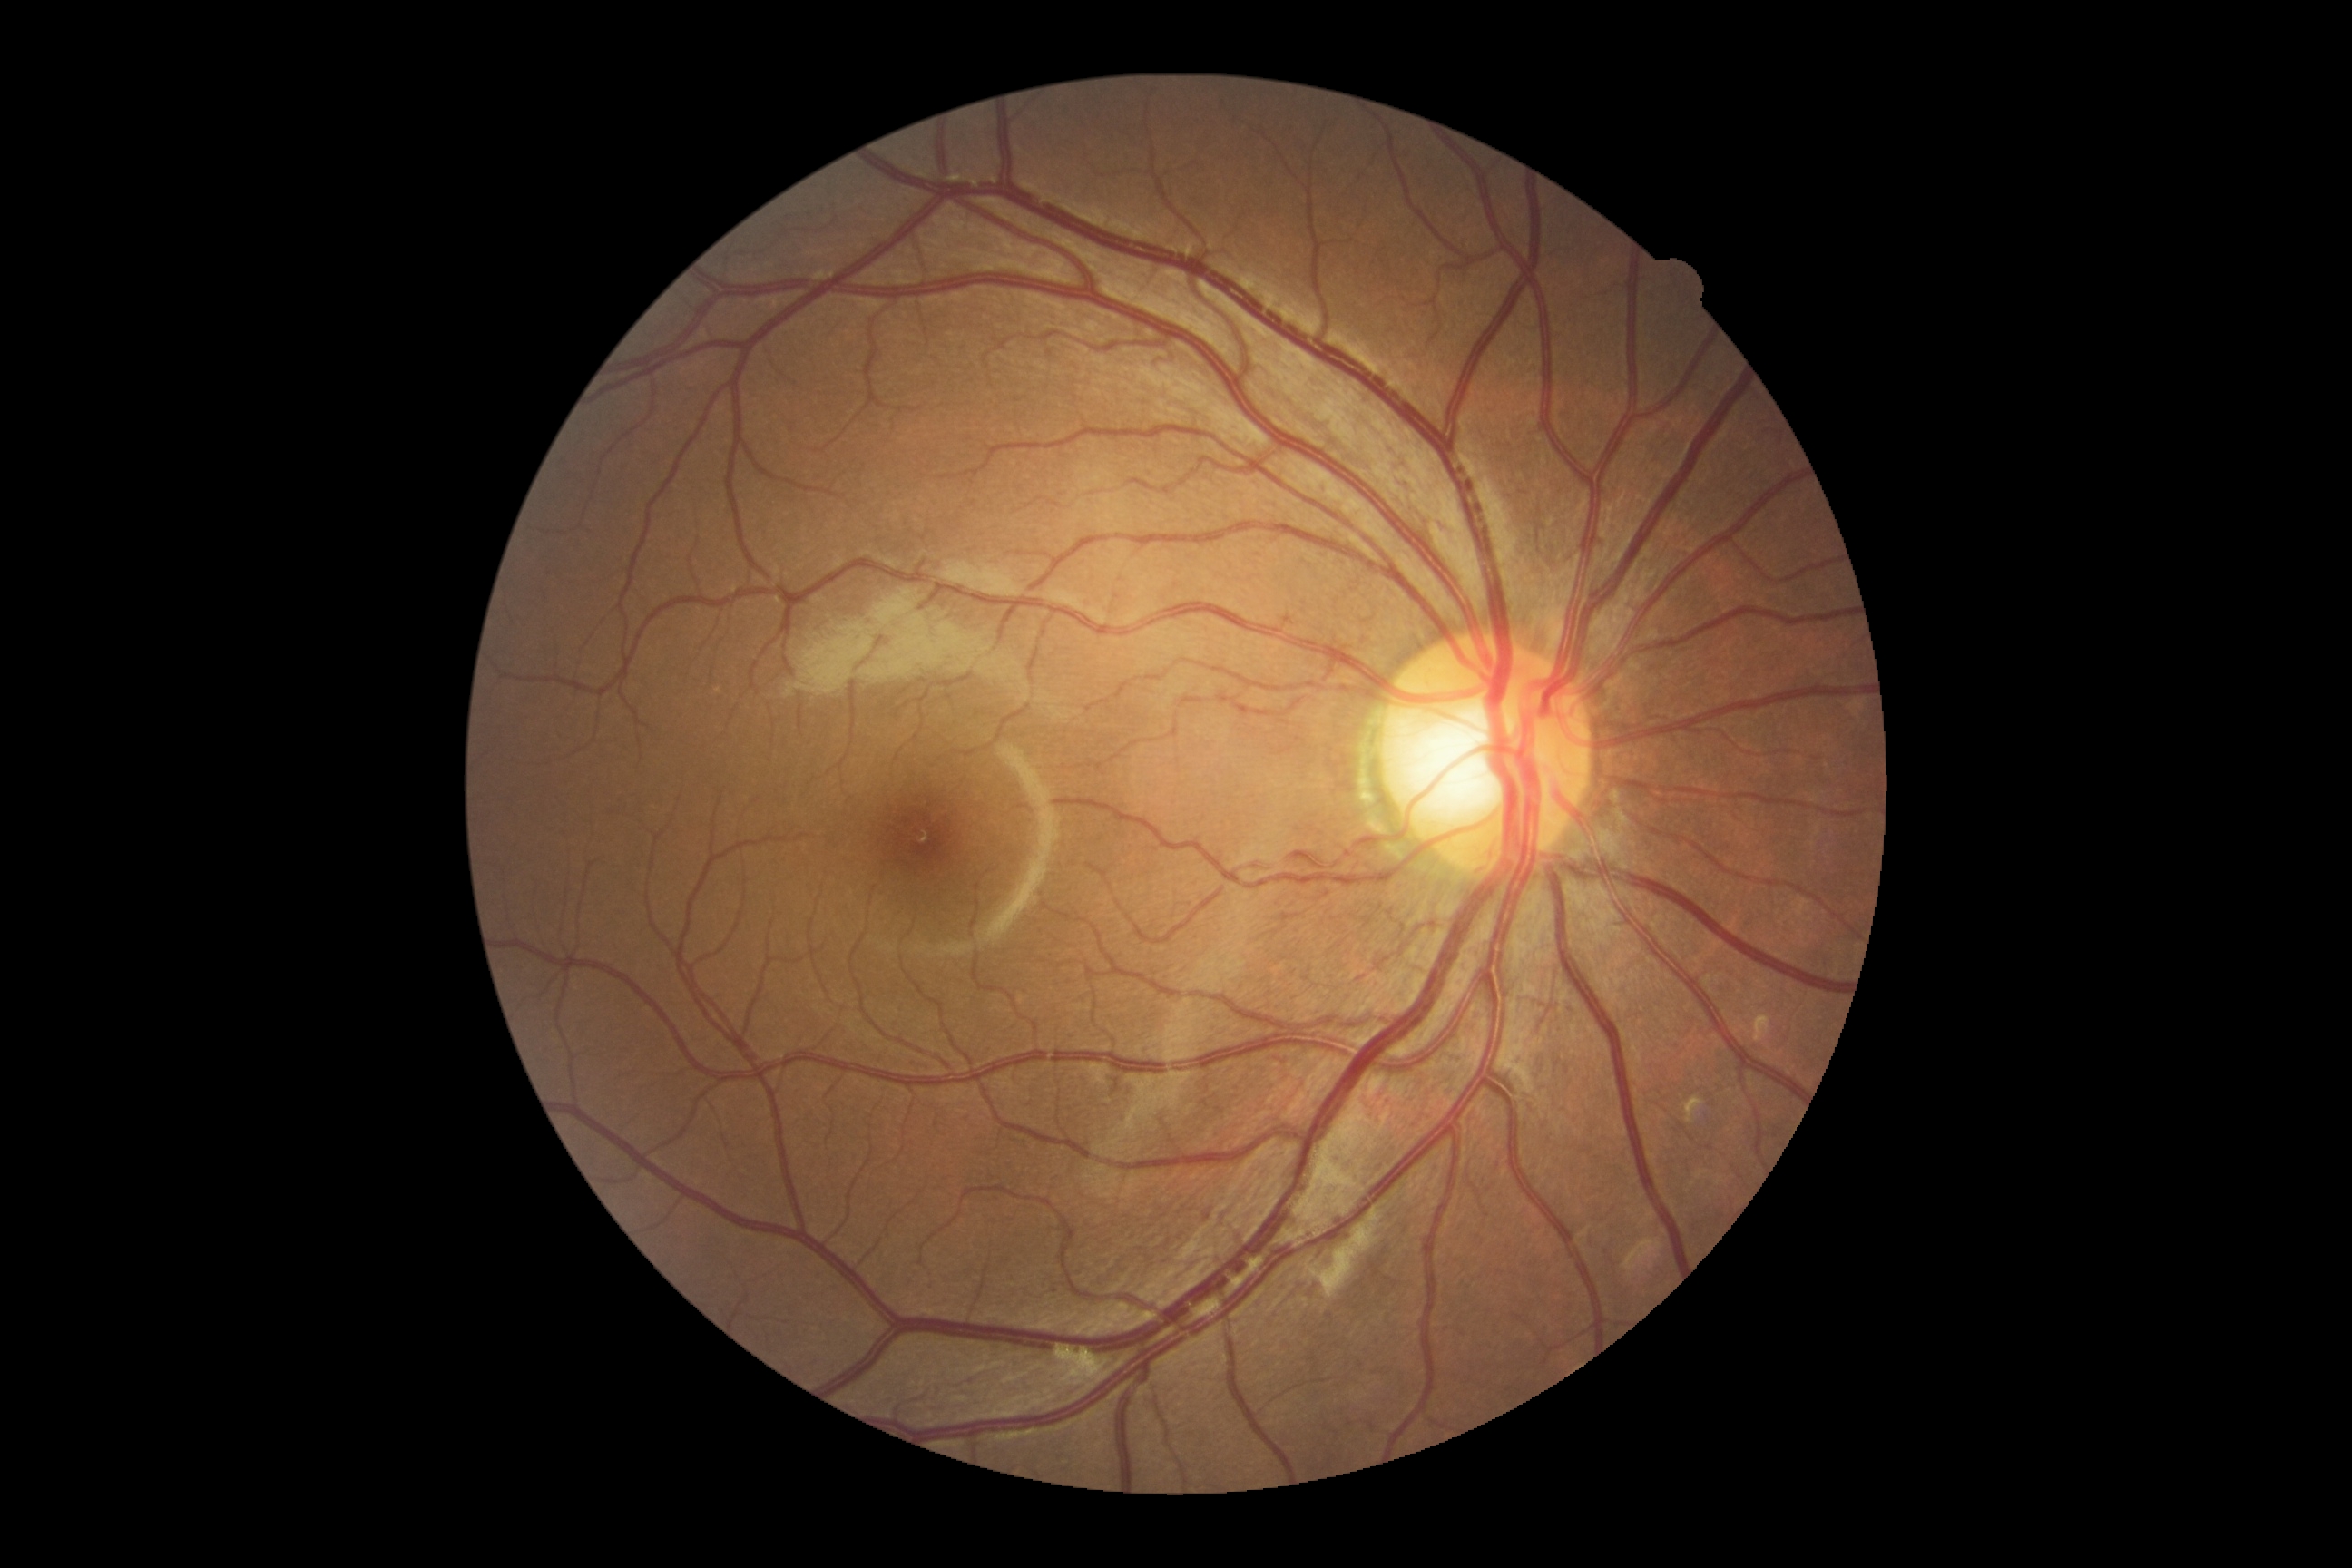

Diabetic retinopathy (DR): no apparent diabetic retinopathy (grade 0). No DR findings.